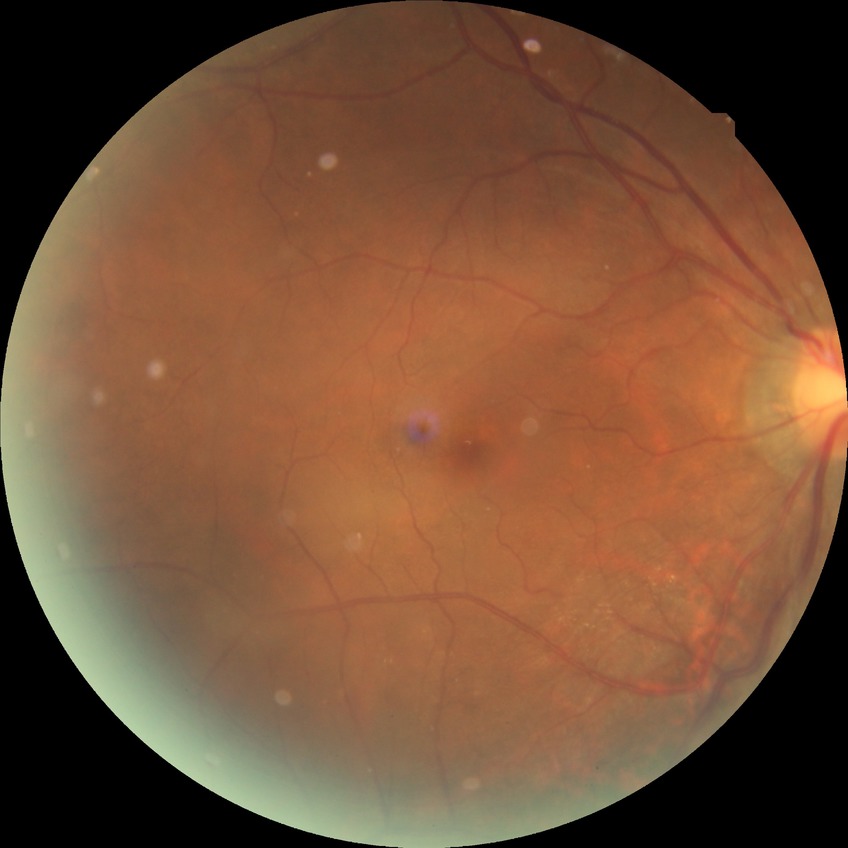

DR stage: NDR.